2212x1661px. Intraocular pressure (IOP) 14 mmHg. Patient age: 79 years. Captured without pupil dilation. Axial length 22.76 mm — 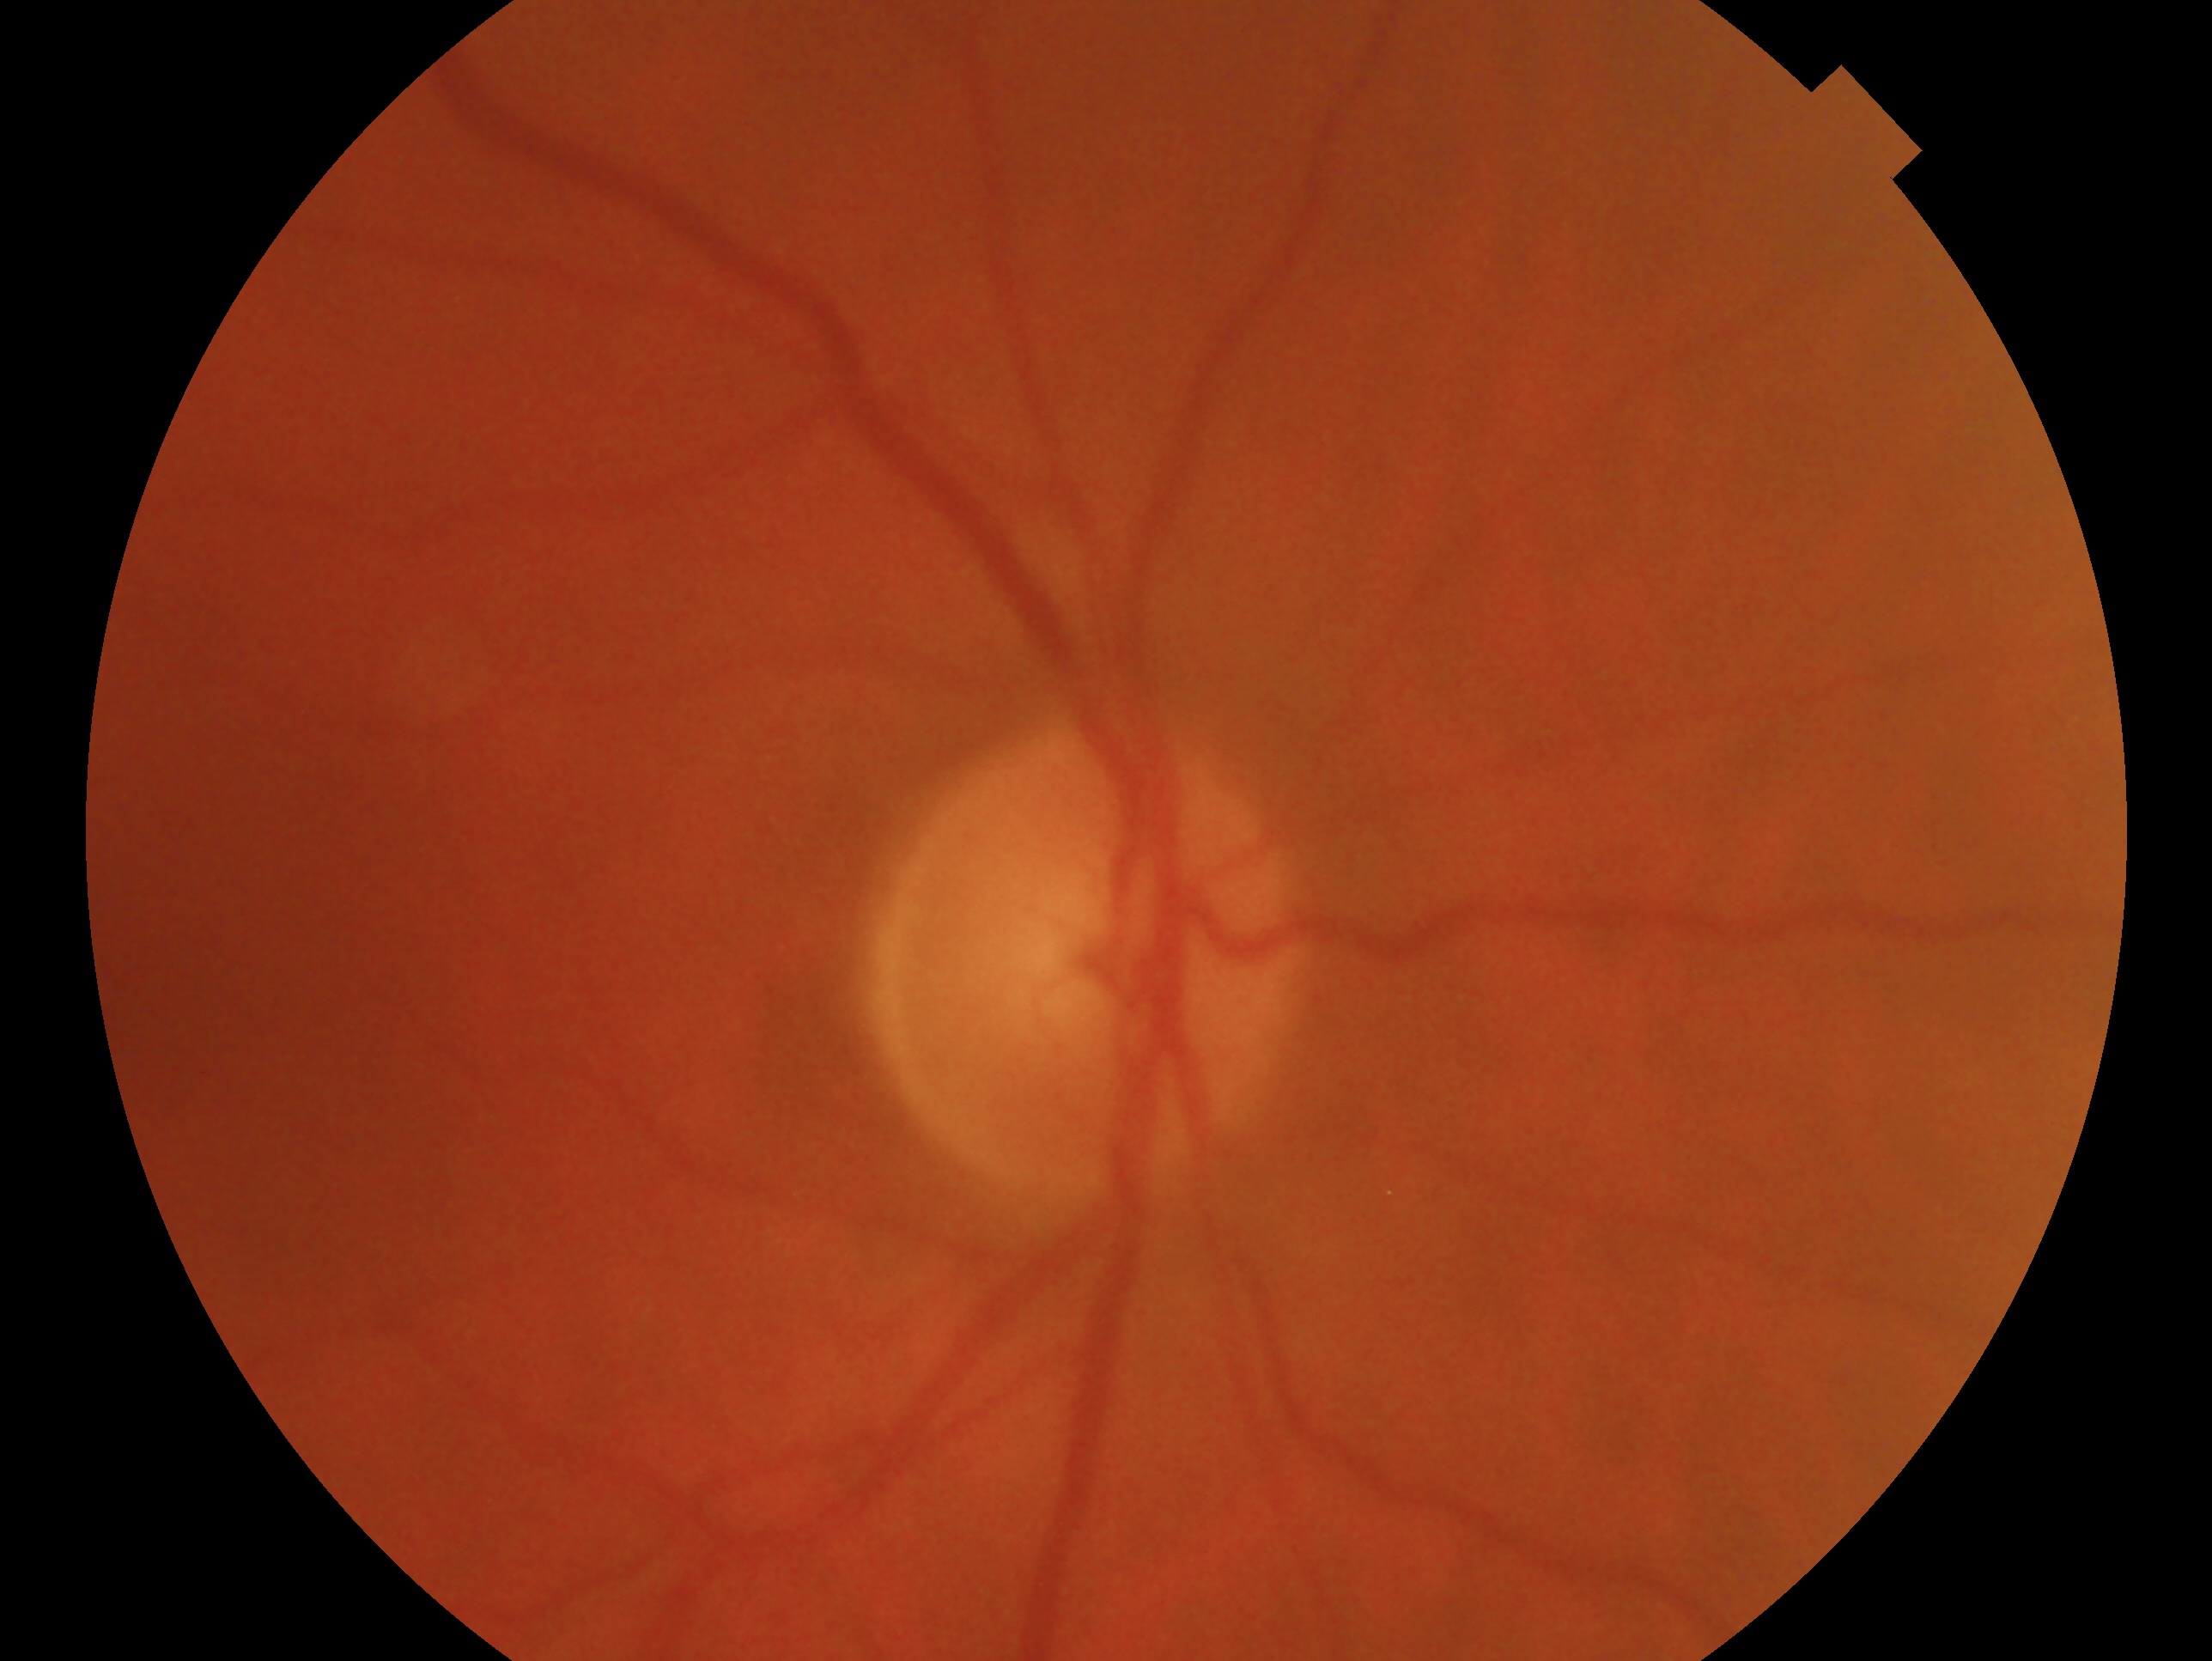
{
  "glaucoma_dx": "no evidence of glaucoma",
  "eye": "oculus dexter"
}